Fundus photo; 1536x1152px:
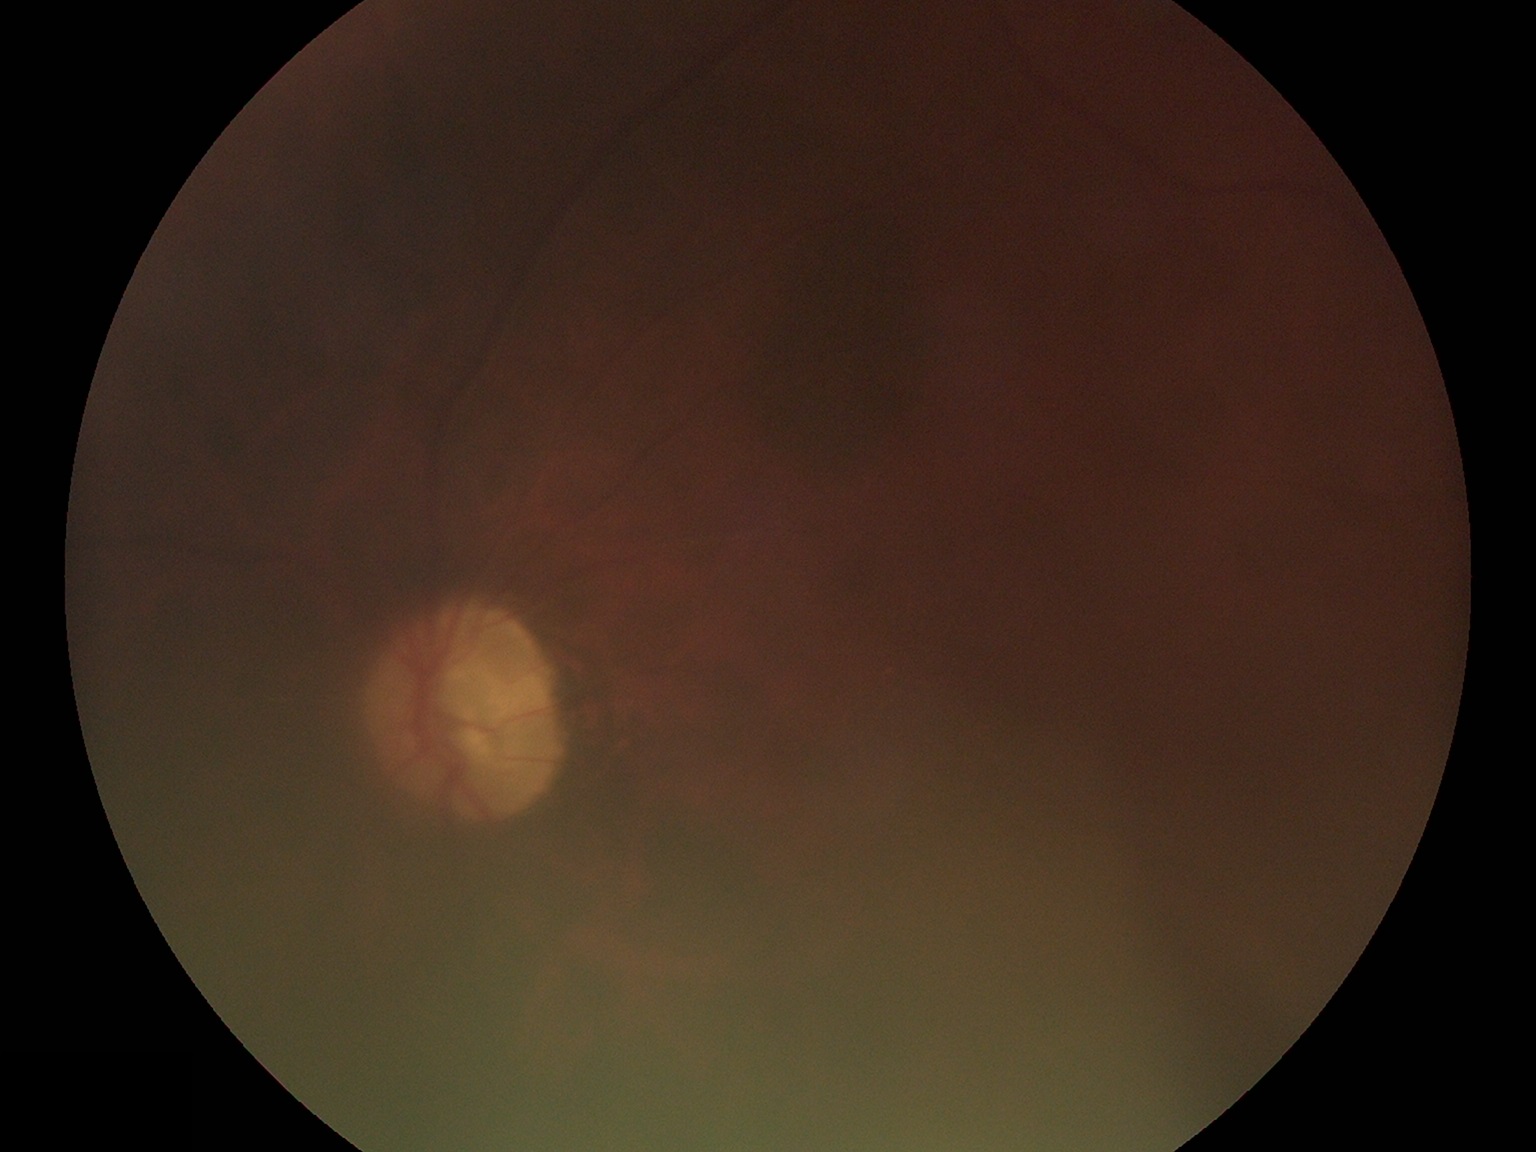
DR grade is 0 (no apparent retinopathy). No apparent diabetic retinopathy.